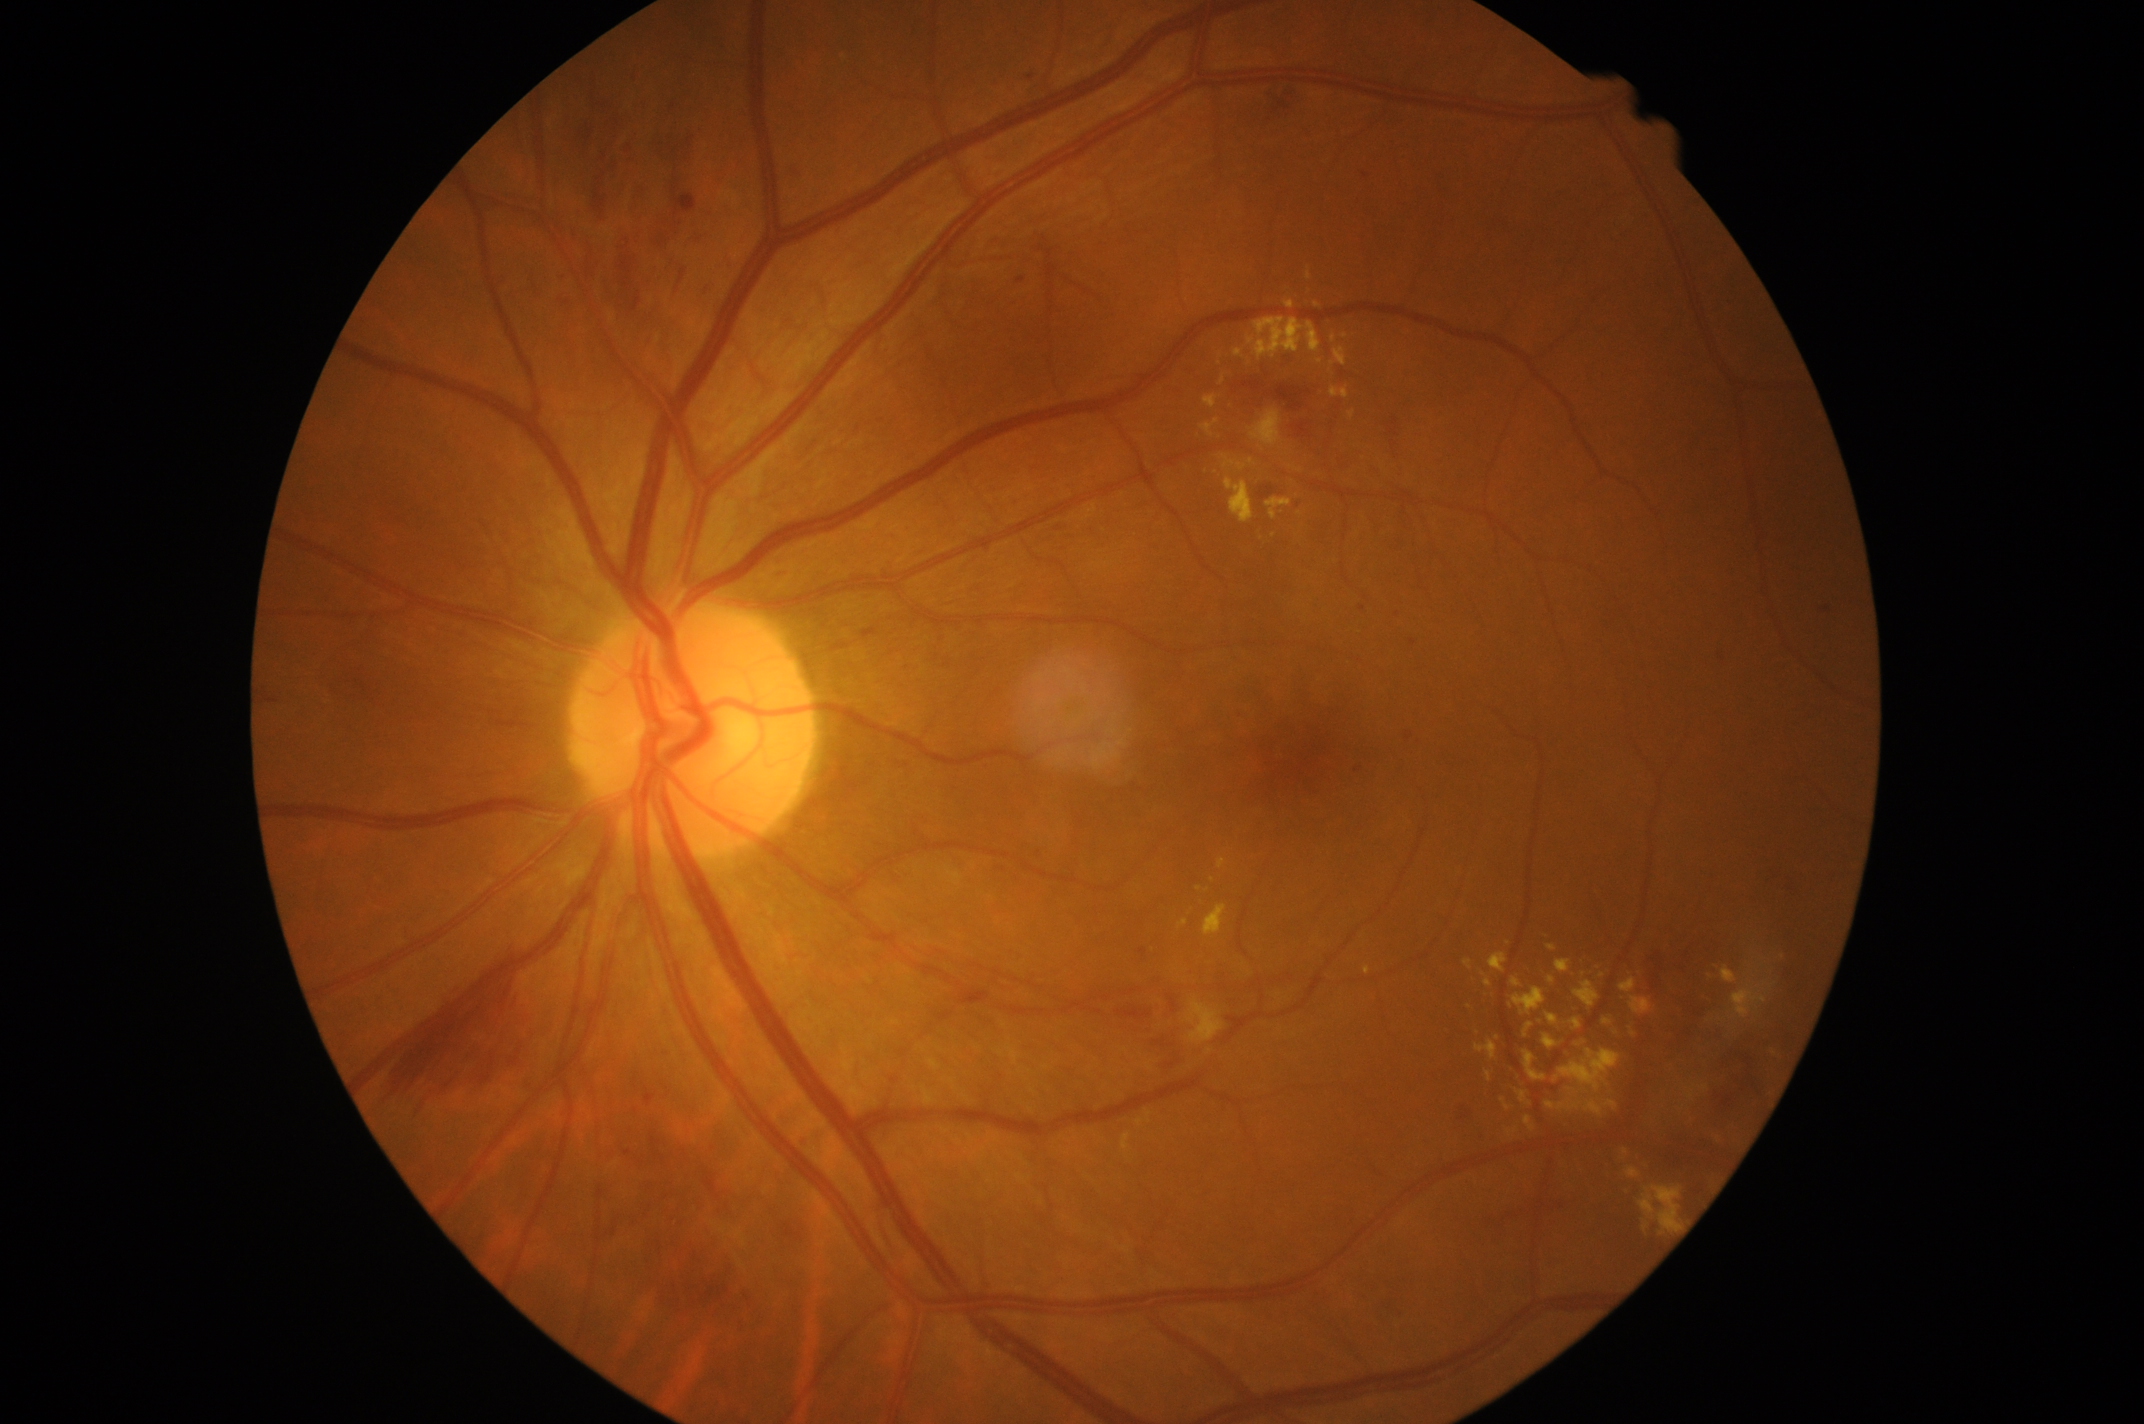

Retinopathy: moderate non-proliferative diabetic retinopathy (grade 2).
The retinopathy is classified as non-proliferative diabetic retinopathy.